NIDEK AFC-230, DR severity per modified Davis staging.
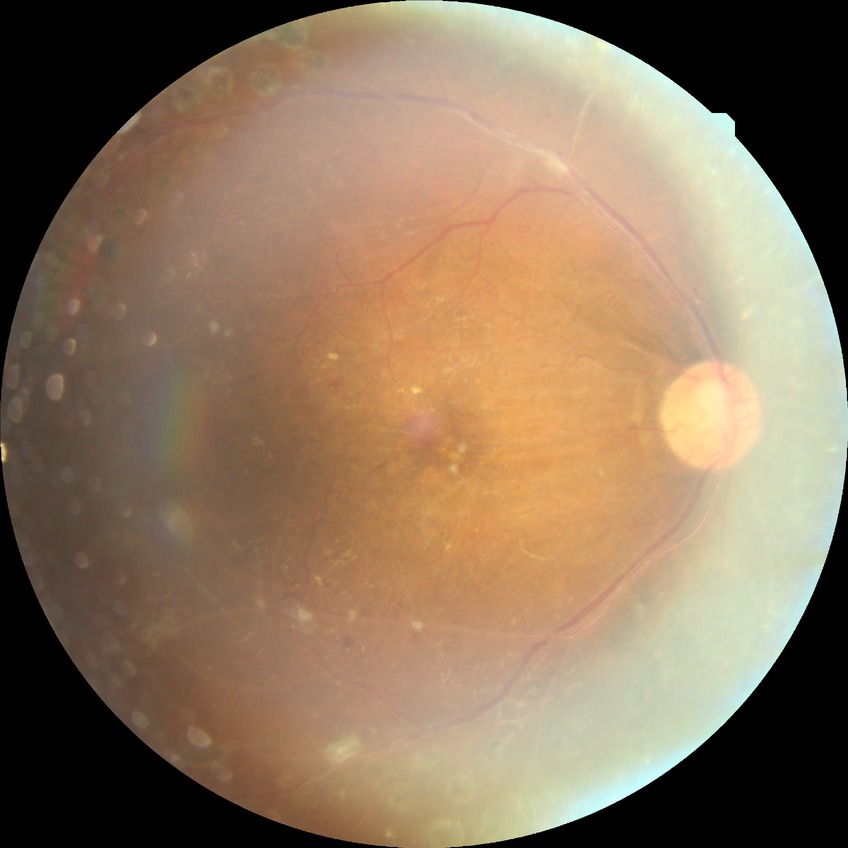

  davis_grade: proliferative diabetic retinopathy (PDR)